FOV: 45 degrees; 1932x1916
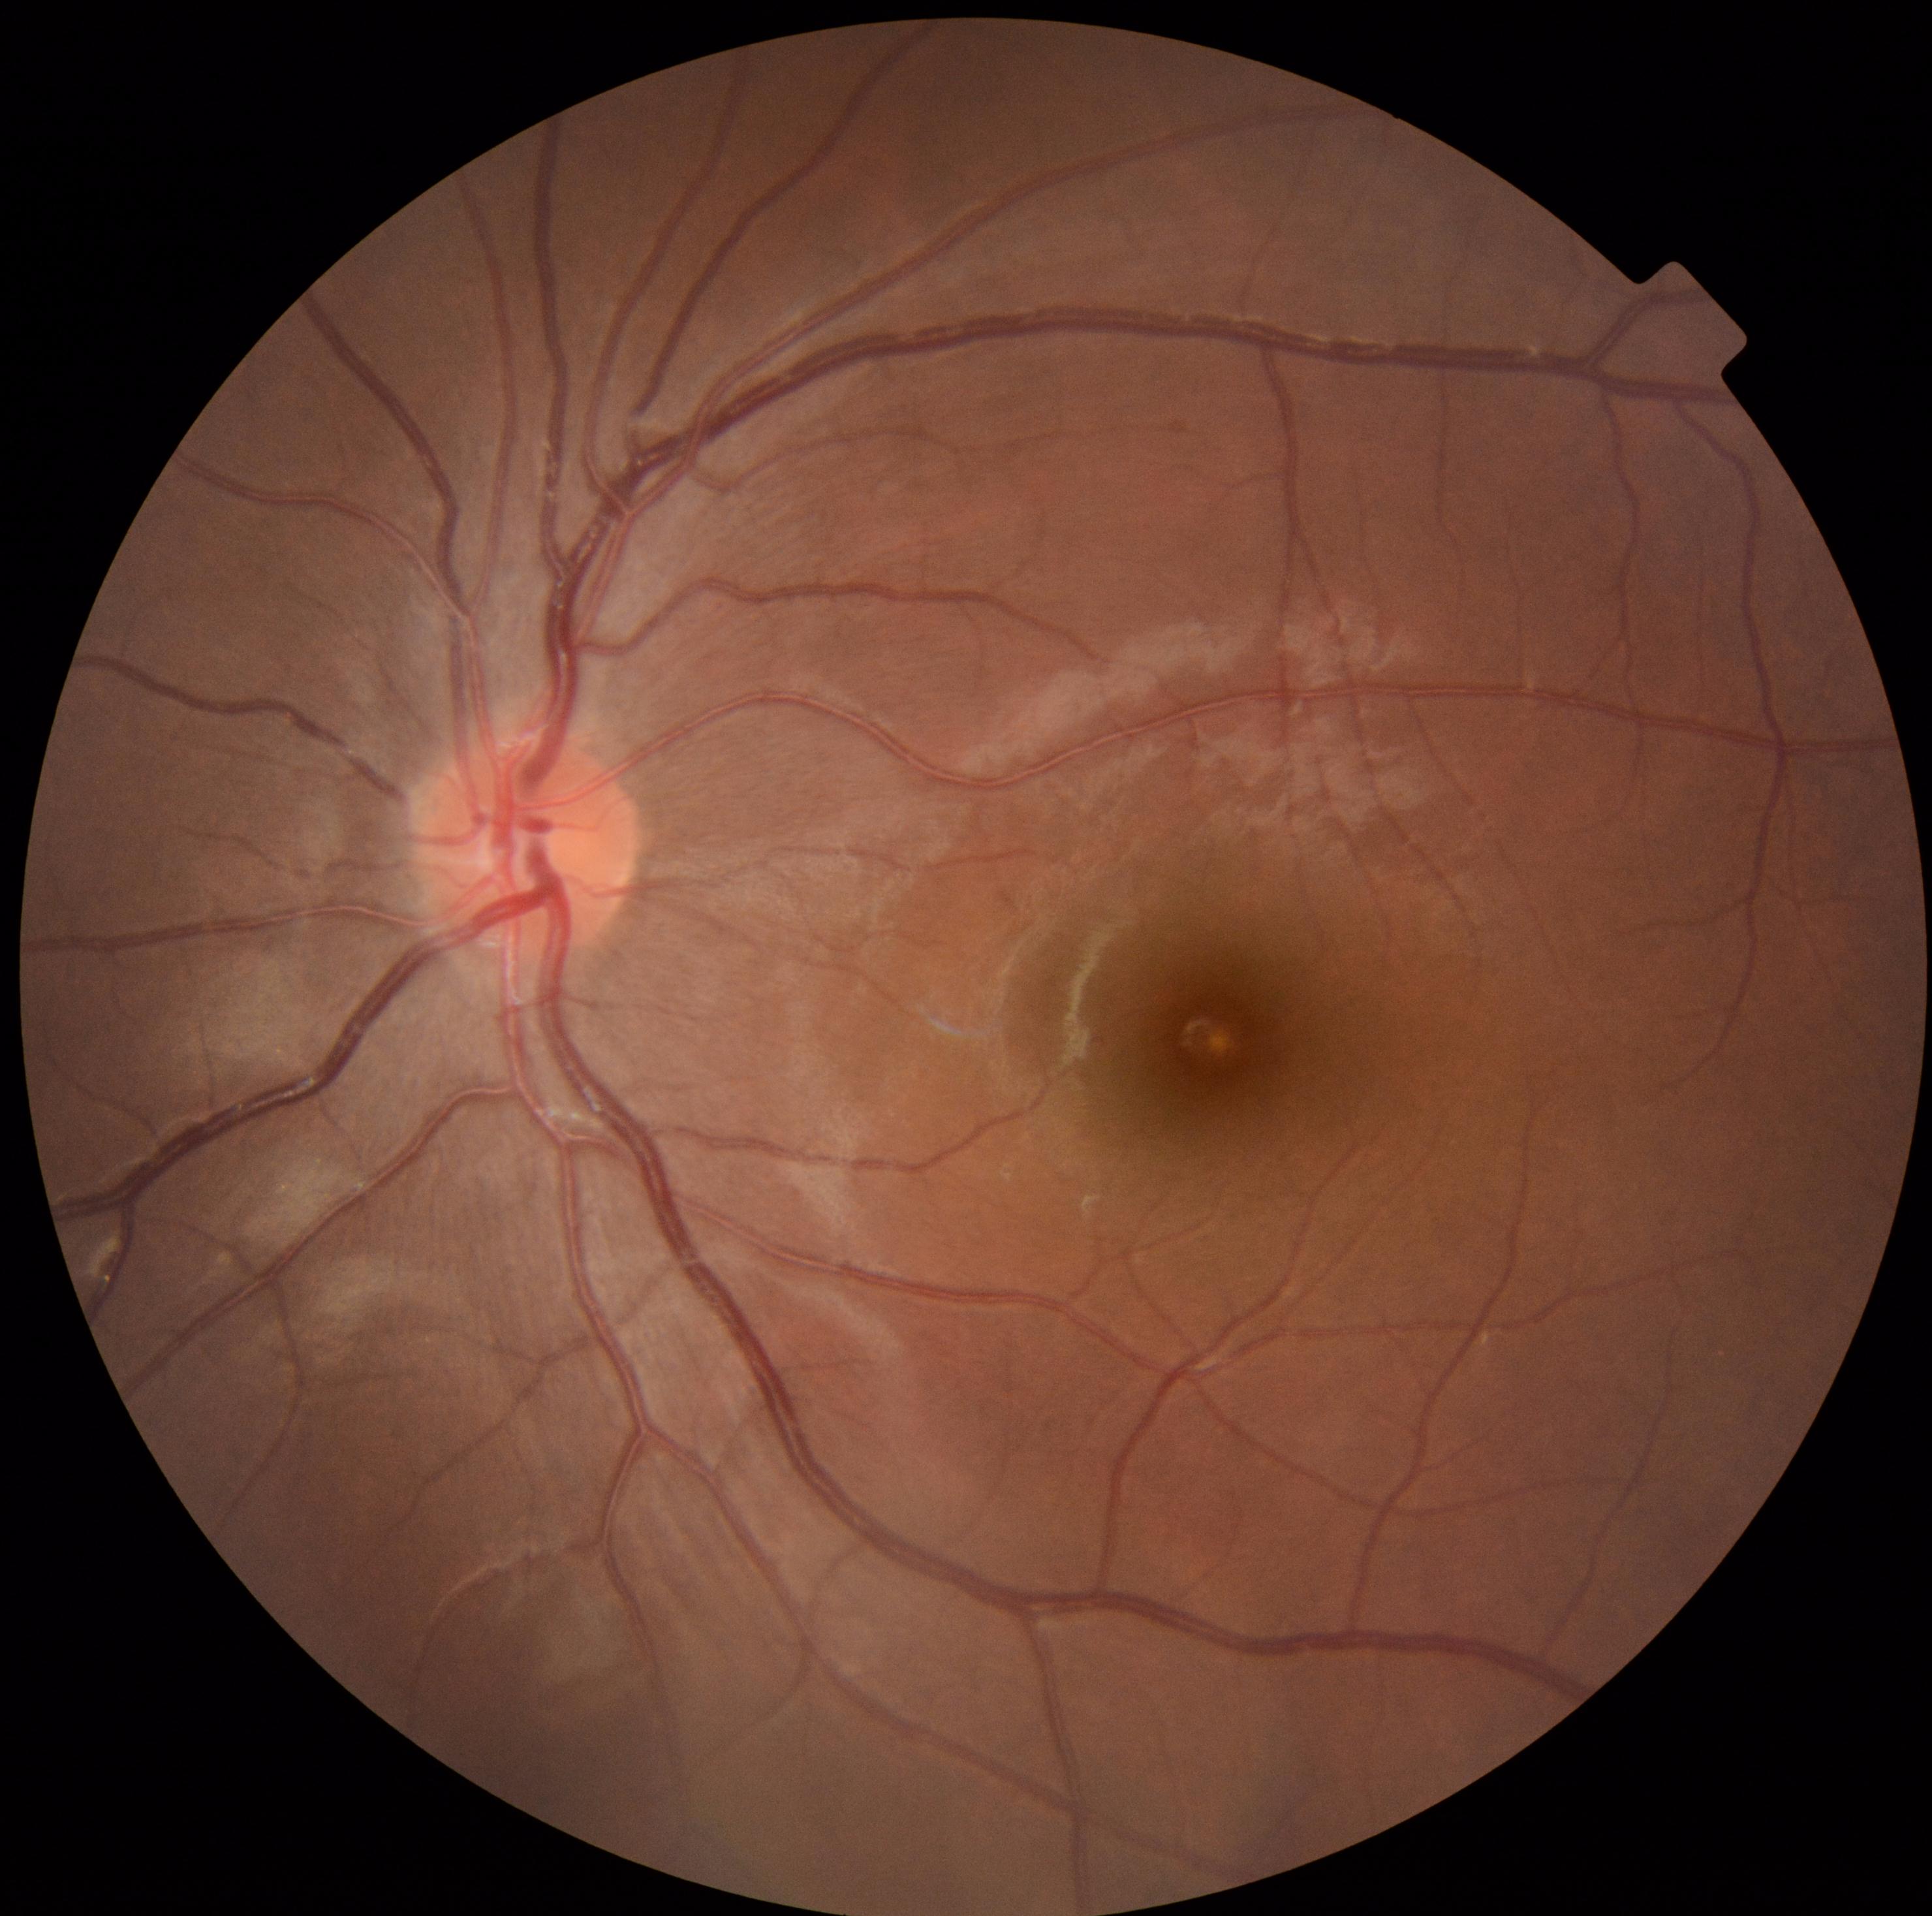
{
  "dr_grade": "0"
}